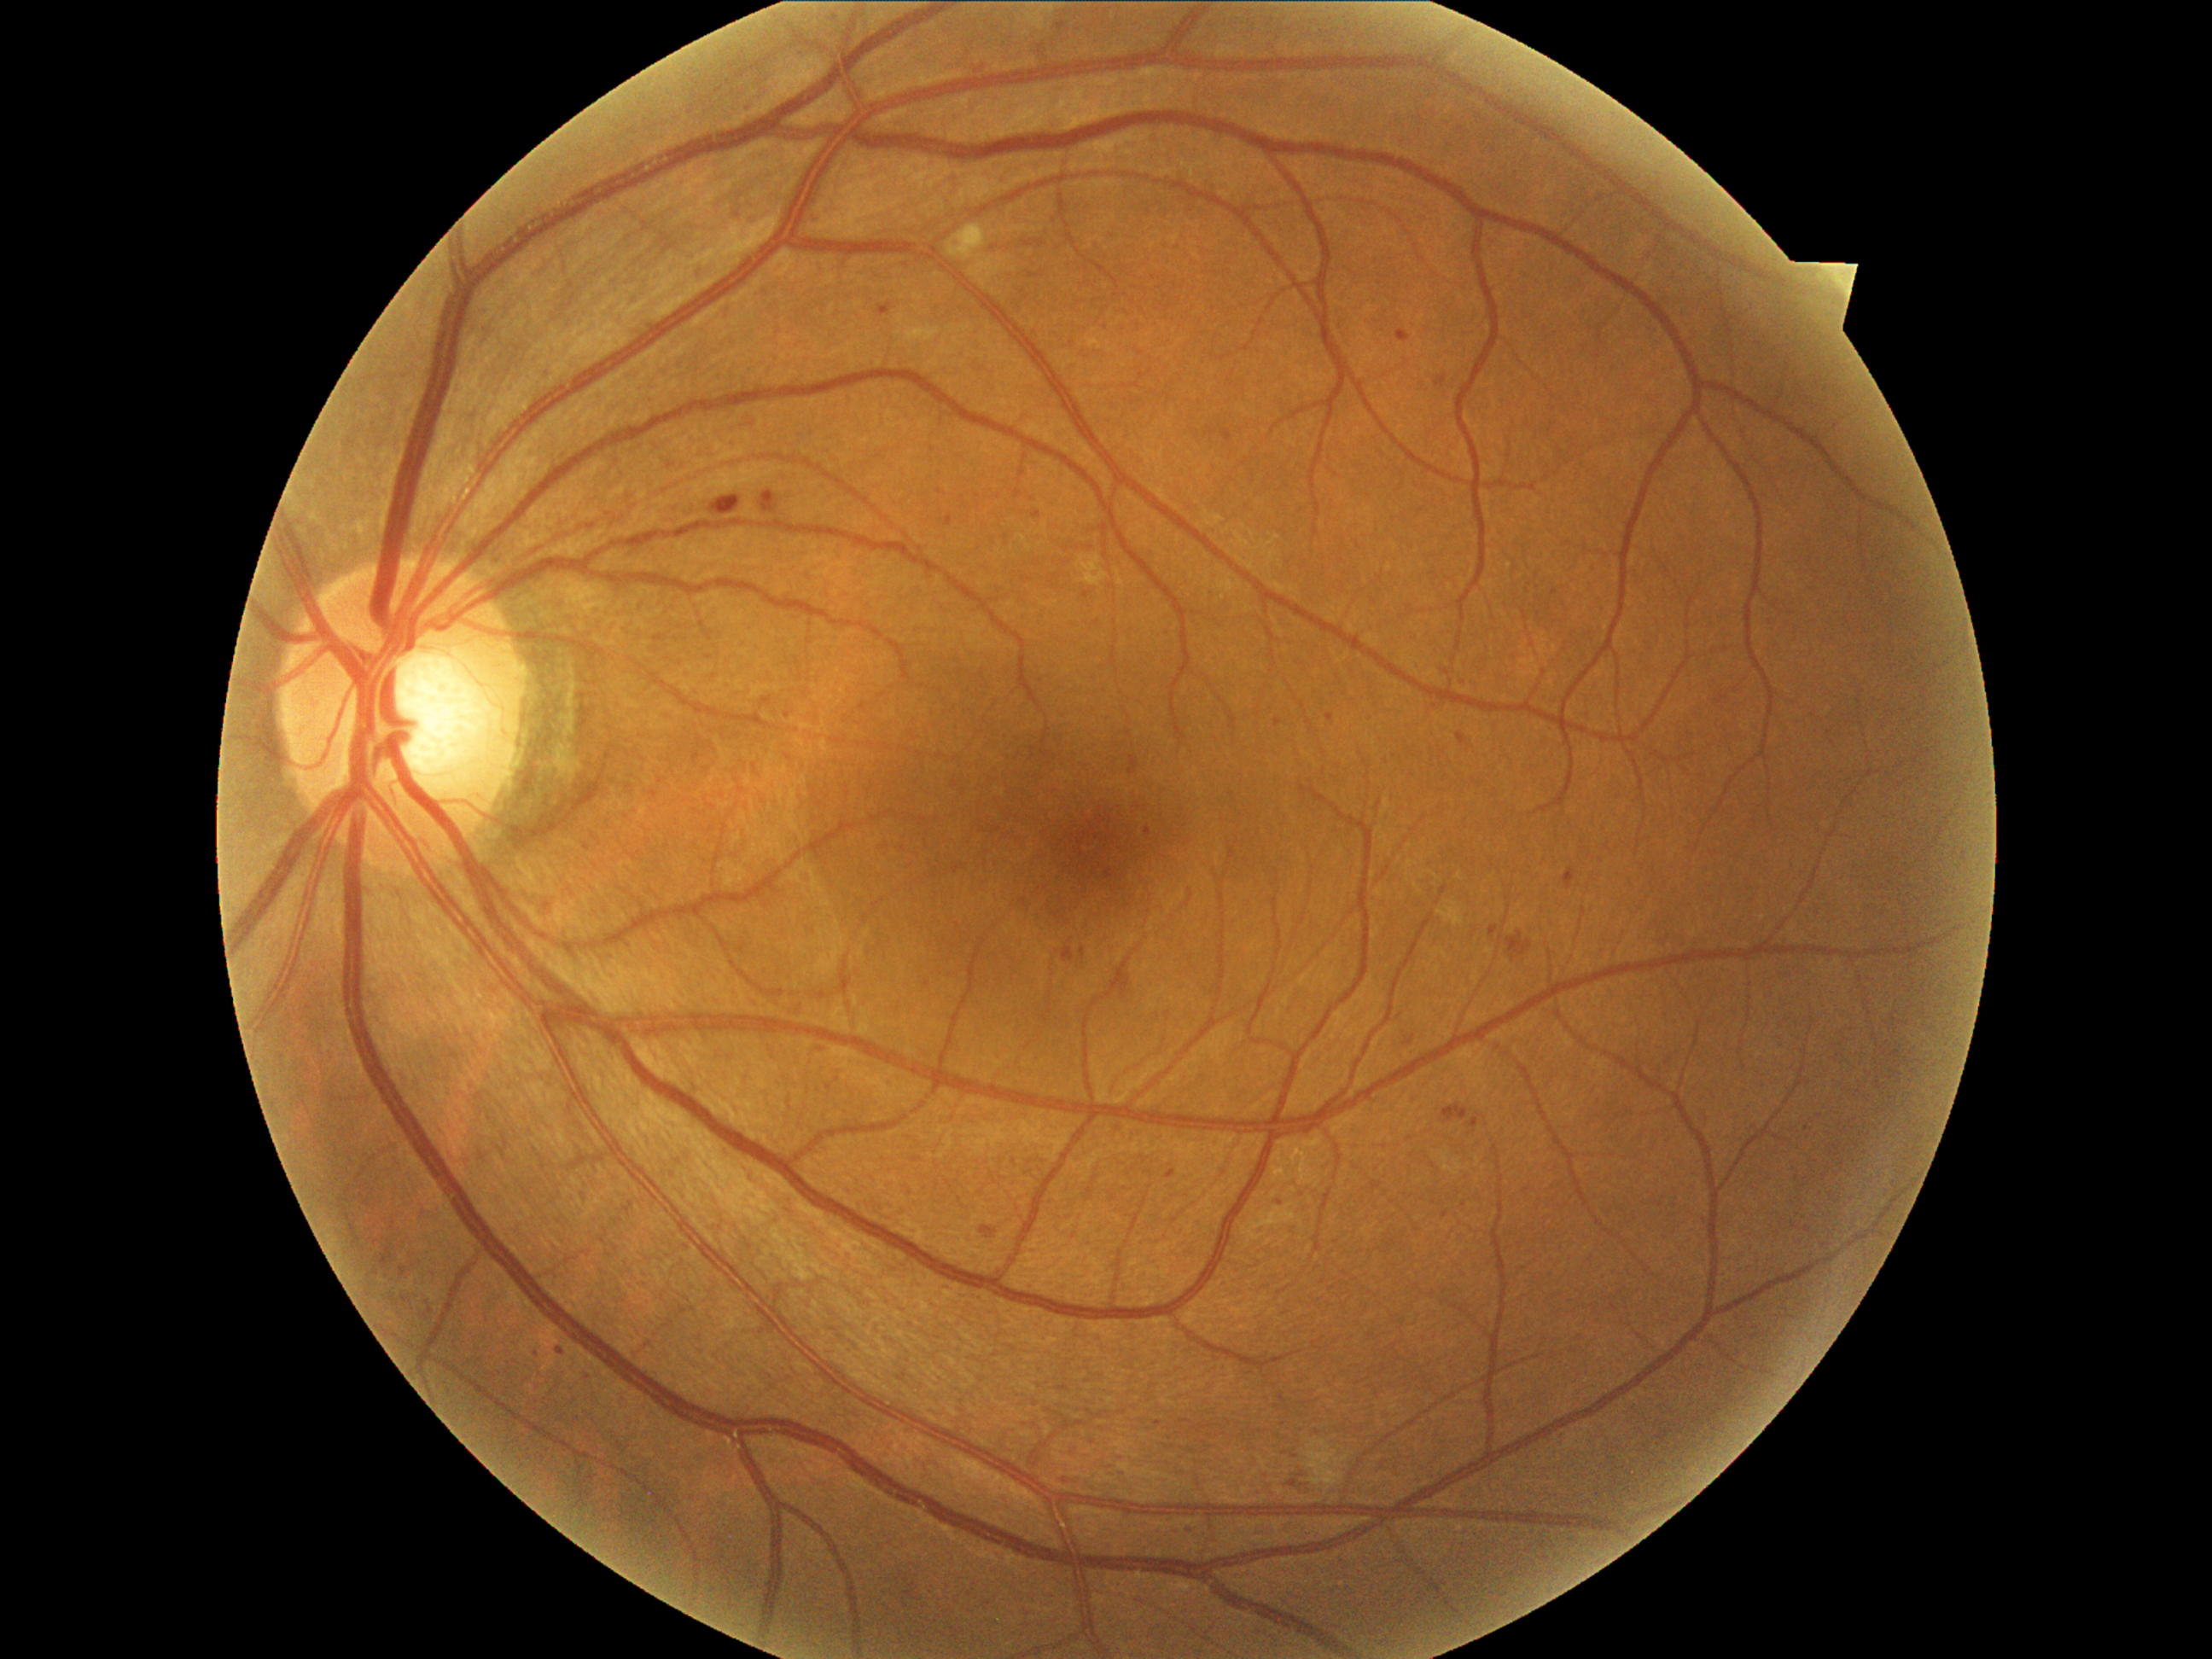

Diabetic retinopathy (DR): moderate non-proliferative diabetic retinopathy (grade 2)
Representative lesions:
hard exudates (EXs): none
soft exudates (SEs): {"x1": 948, "y1": 224, "x2": 987, "y2": 262}; {"x1": 1305, "y1": 1436, "x2": 1353, "y2": 1494}
hemorrhages (HEs): {"x1": 1129, "y1": 757, "x2": 1139, "y2": 776}; {"x1": 1506, "y1": 933, "x2": 1534, "y2": 962}; {"x1": 1441, "y1": 1105, "x2": 1470, "y2": 1124}; {"x1": 759, "y1": 492, "x2": 779, "y2": 515}; {"x1": 1289, "y1": 1479, "x2": 1310, "y2": 1496}; {"x1": 709, "y1": 496, "x2": 742, "y2": 516}; {"x1": 1117, "y1": 972, "x2": 1132, "y2": 999}
microaneurysms (MAs) (continued): {"x1": 1327, "y1": 714, "x2": 1334, "y2": 723}; {"x1": 1057, "y1": 23, "x2": 1066, "y2": 30}; {"x1": 975, "y1": 67, "x2": 986, "y2": 74}; {"x1": 989, "y1": 242, "x2": 1001, "y2": 252}; {"x1": 1167, "y1": 1170, "x2": 1175, "y2": 1180}; {"x1": 1062, "y1": 946, "x2": 1074, "y2": 962}; {"x1": 1221, "y1": 431, "x2": 1233, "y2": 443}; {"x1": 1564, "y1": 868, "x2": 1576, "y2": 890}; {"x1": 535, "y1": 1346, "x2": 542, "y2": 1356}; {"x1": 400, "y1": 1266, "x2": 405, "y2": 1278}; {"x1": 378, "y1": 1240, "x2": 397, "y2": 1271}; {"x1": 1470, "y1": 1119, "x2": 1479, "y2": 1129}; {"x1": 878, "y1": 303, "x2": 894, "y2": 317}; {"x1": 1441, "y1": 670, "x2": 1450, "y2": 675}; {"x1": 1489, "y1": 928, "x2": 1499, "y2": 938}; {"x1": 1081, "y1": 948, "x2": 1085, "y2": 957}
Additional small MAs near [x=428, y=1303]; [x=1065, y=1481]; [x=1042, y=47]